NIDEK AFC-230. Color fundus image. Nonmydriatic. Image size 848x848. Diabetic retinopathy graded by the modified Davis classification. 45 degree fundus photograph: 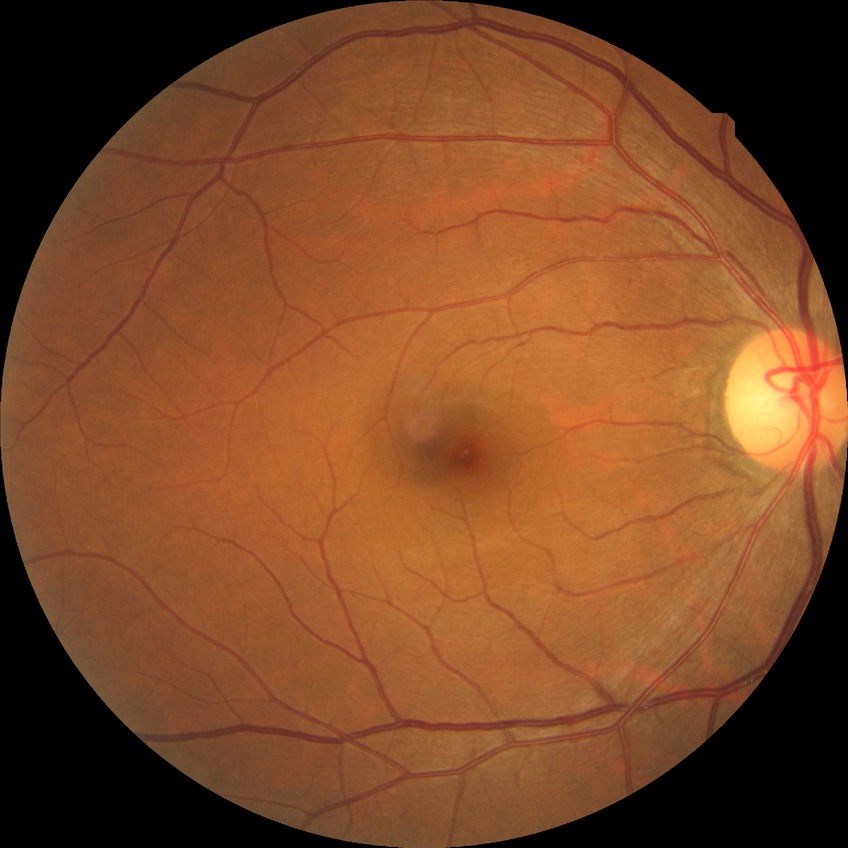 Davis grade: NDR.